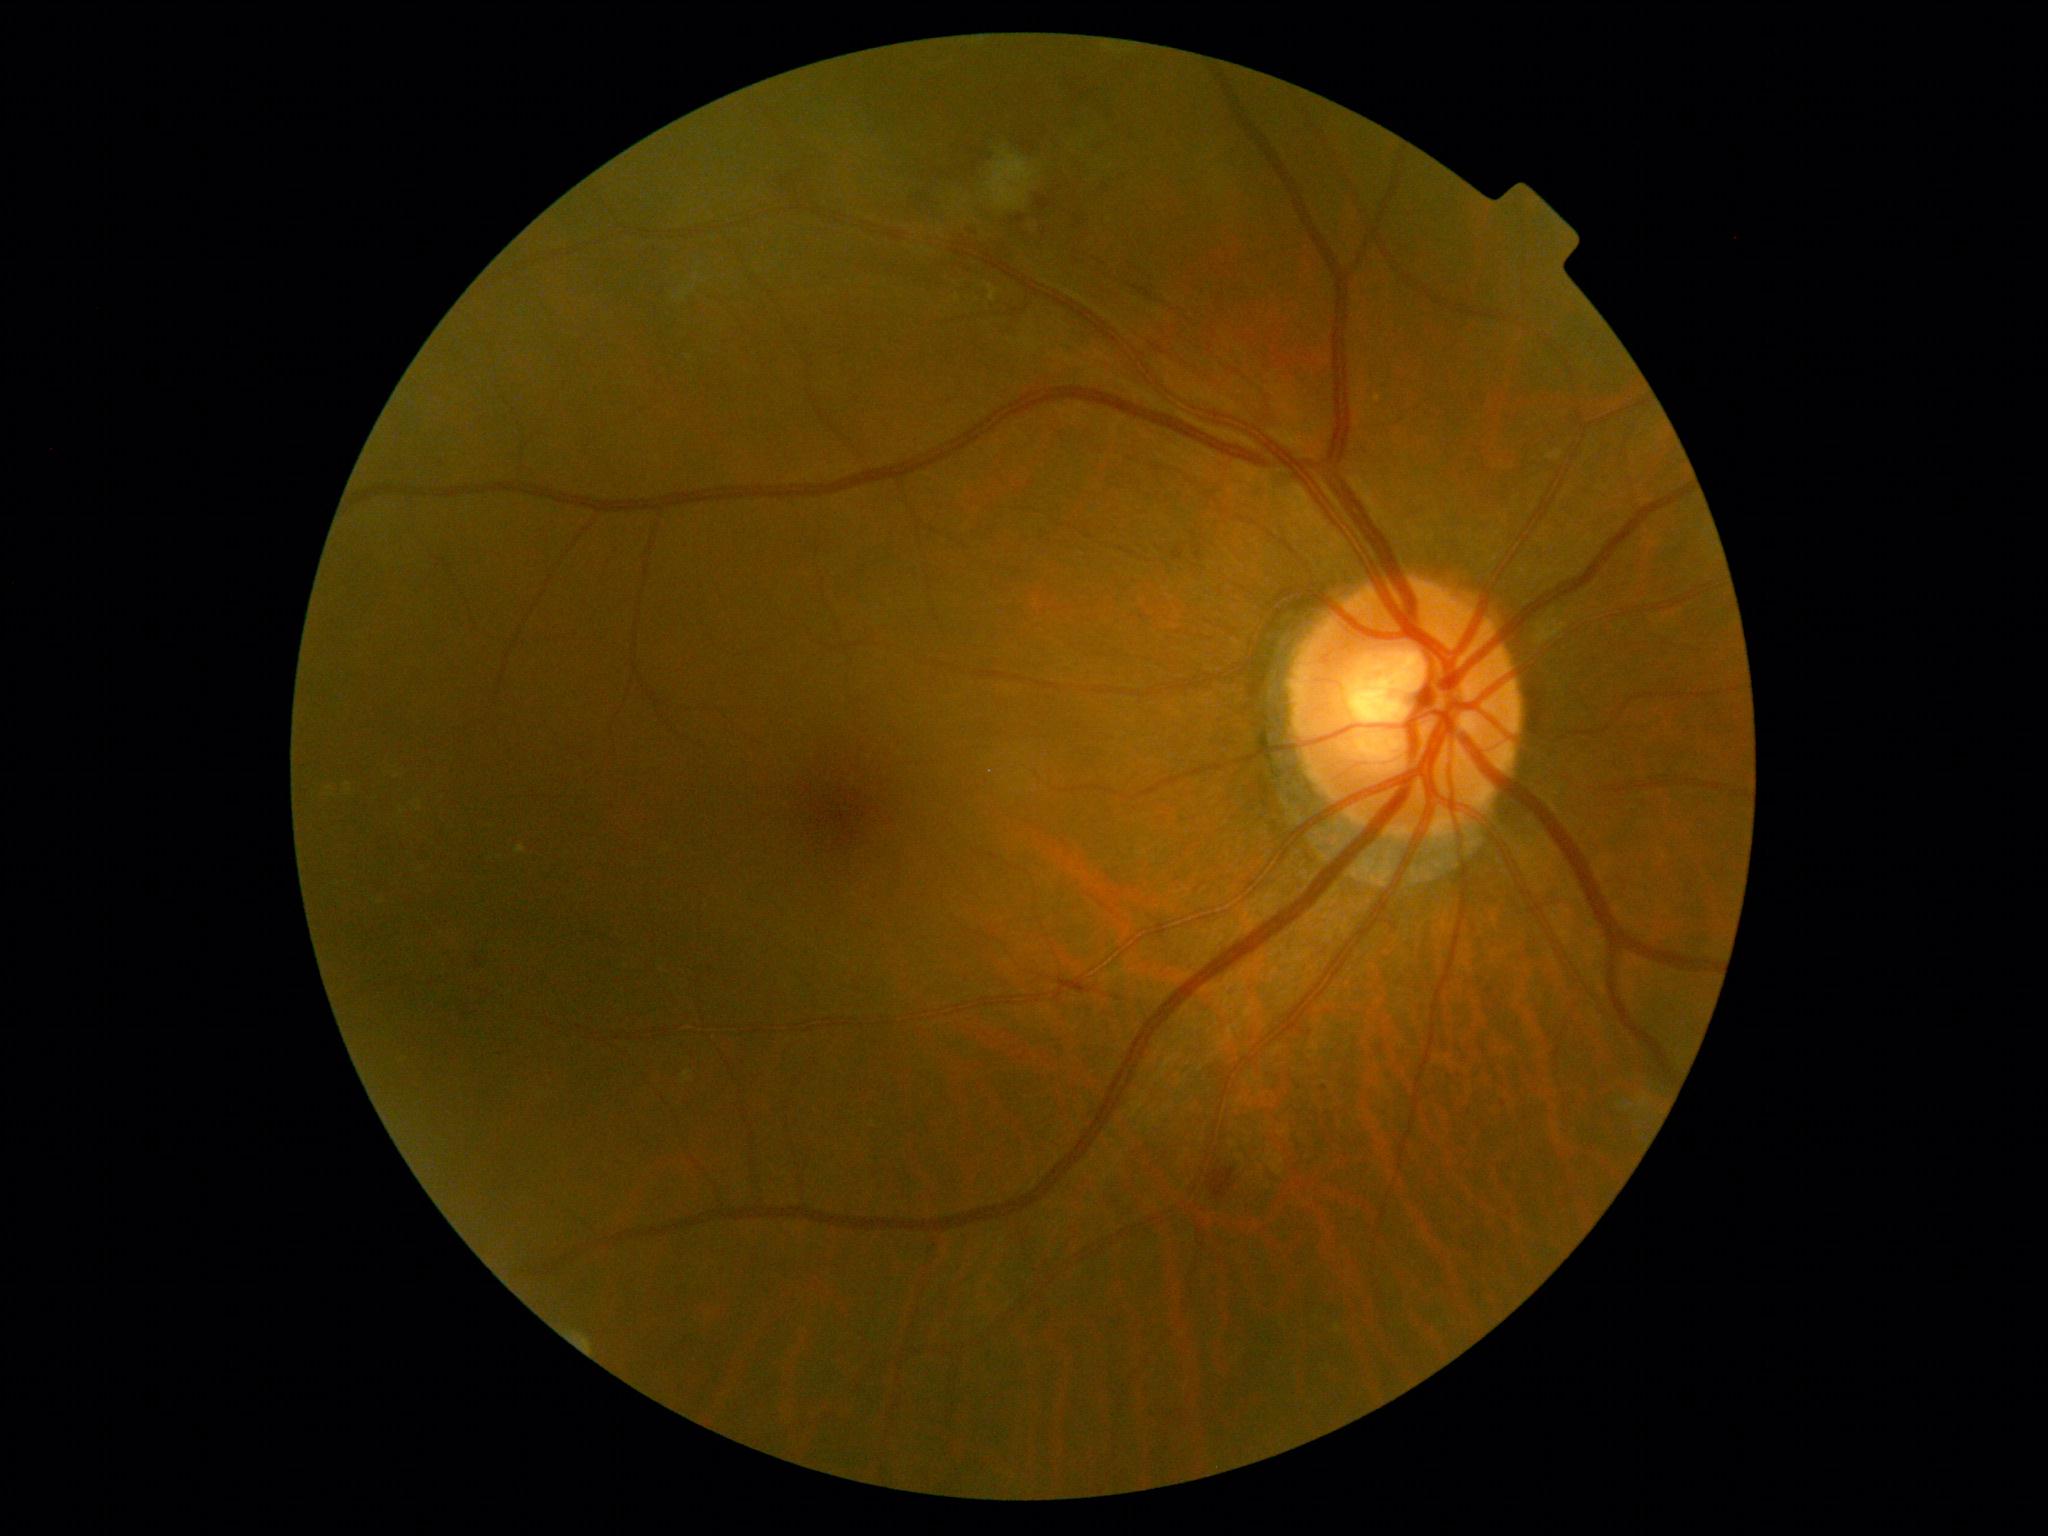
diabetic retinopathy grade@2/4.